Infant wide-field fundus photograph · Clarity RetCam 3, 130° FOV: 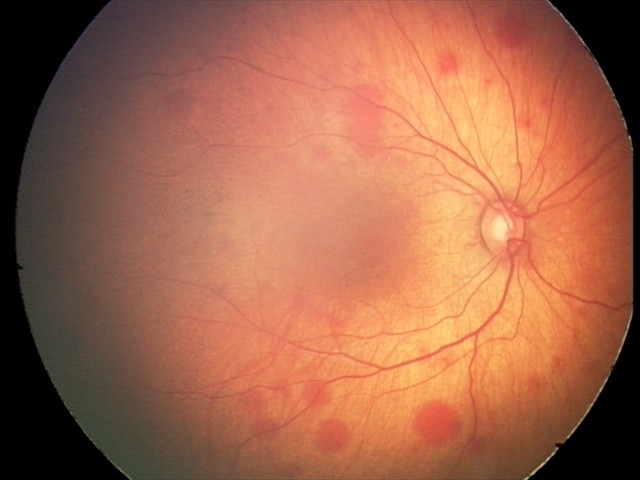

Screening series with retinal hemorrhages.